Infant wide-field retinal image. 1240 by 1240 pixels:
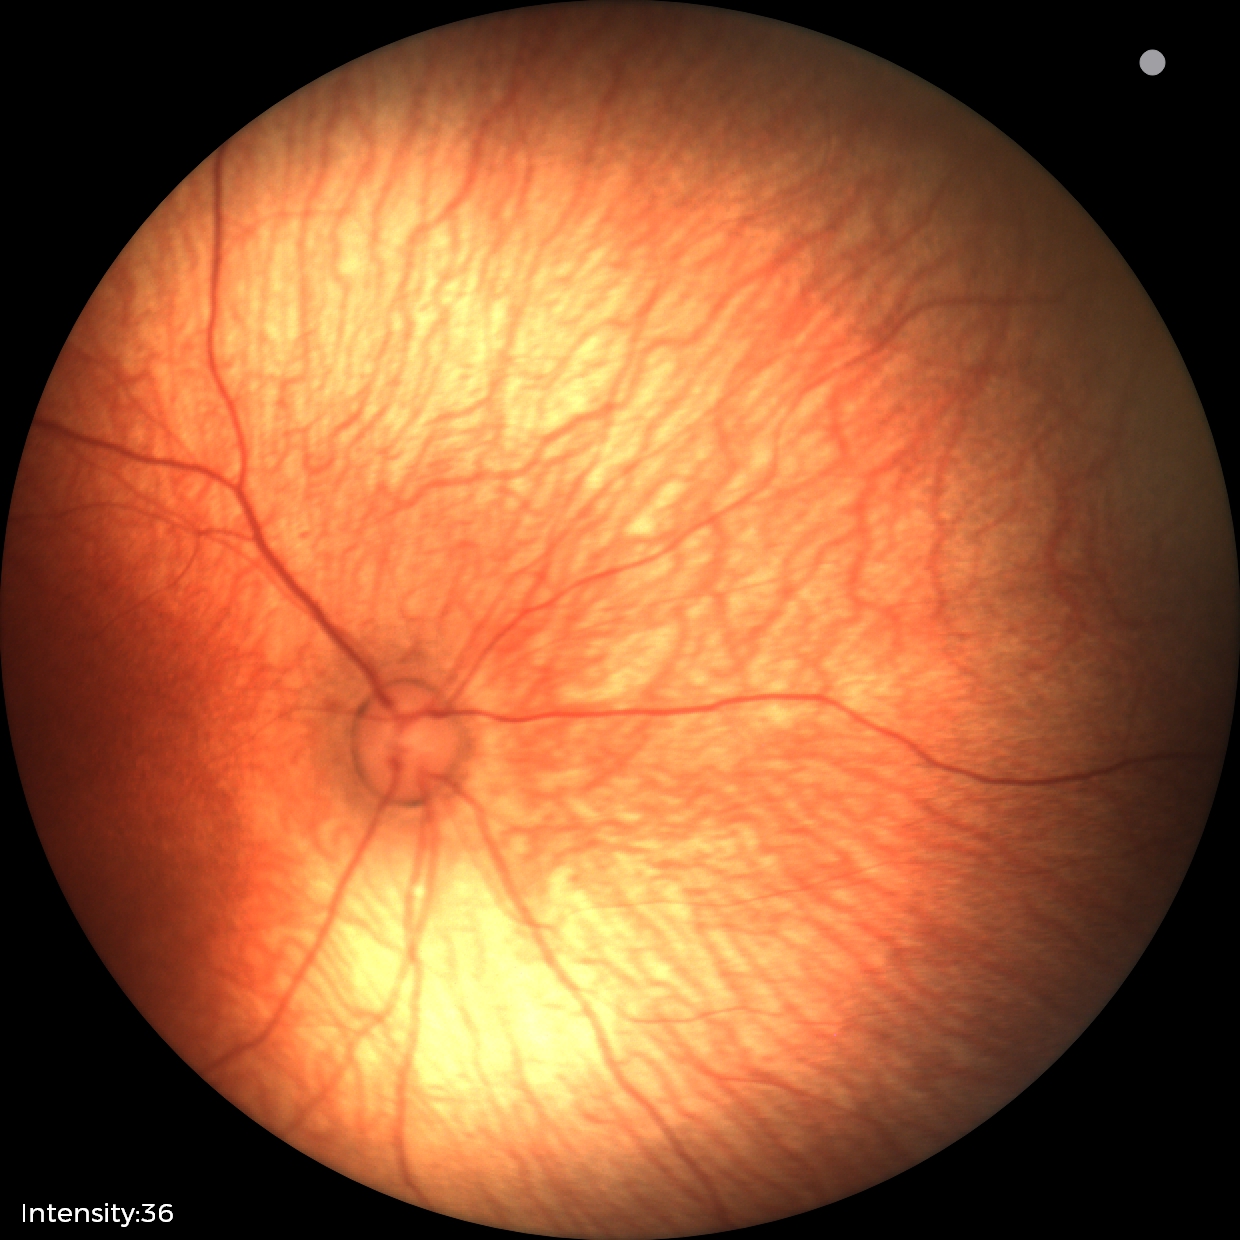

Finding = no abnormalities.